CFP.
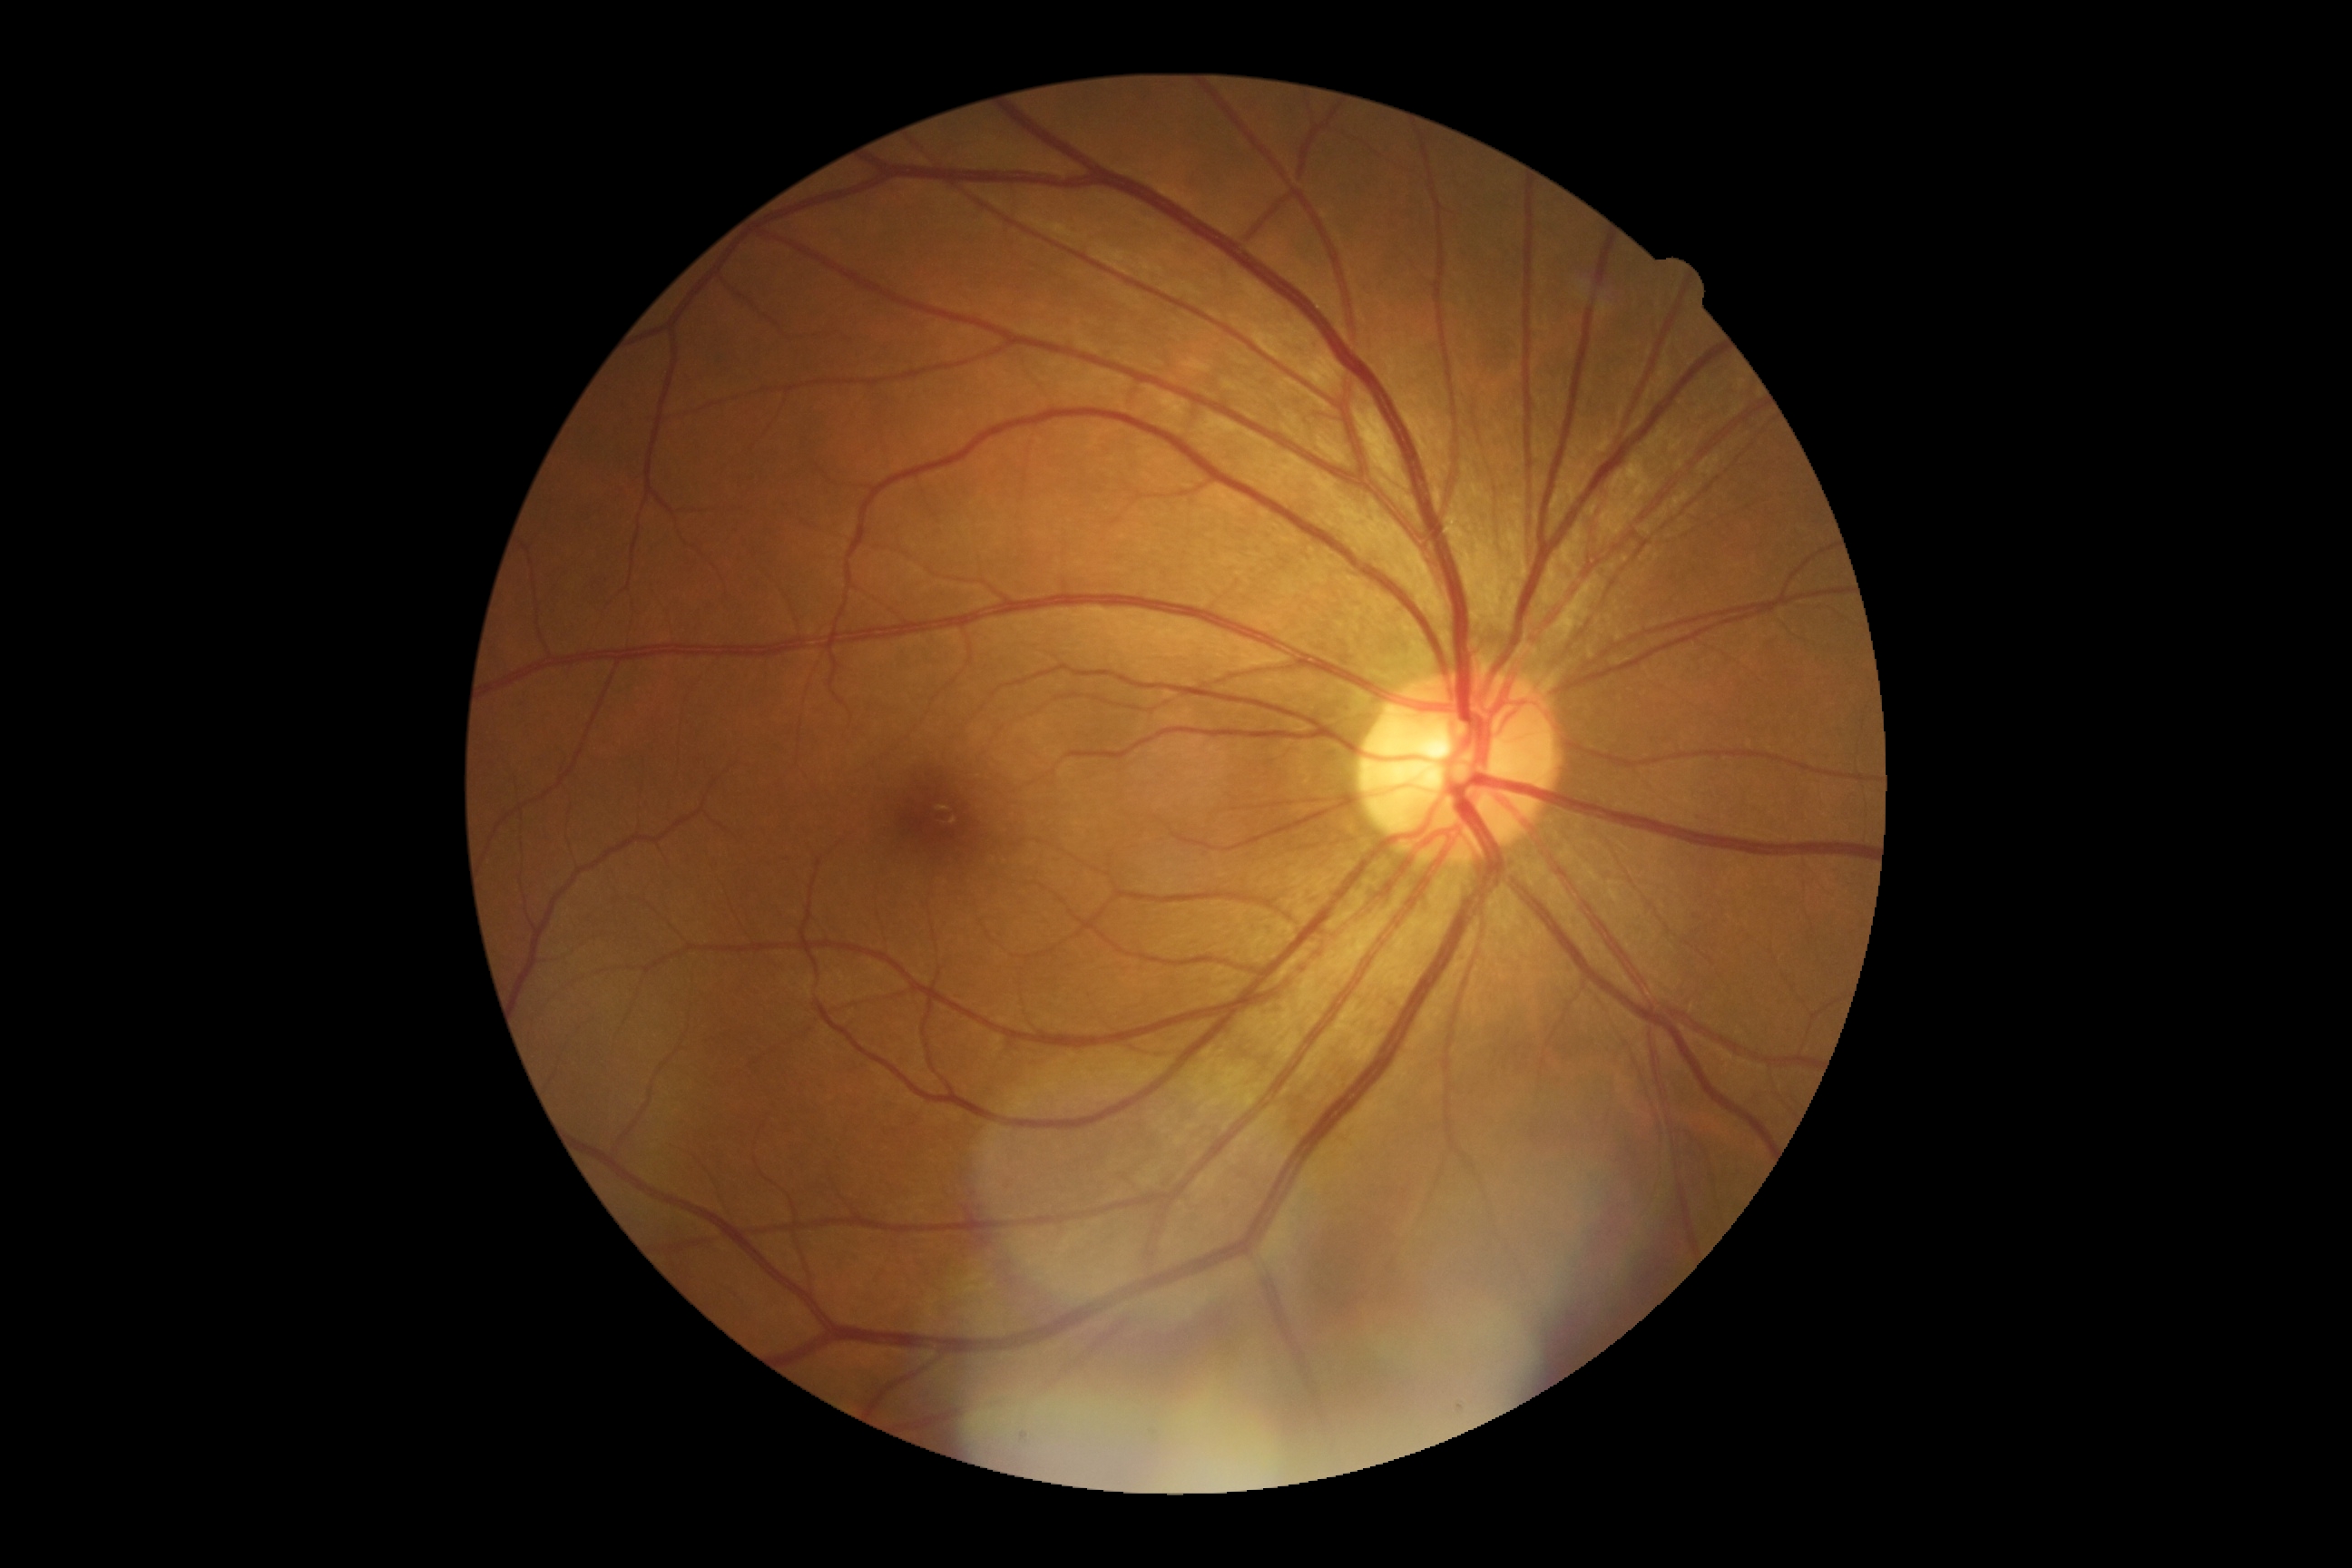
Diabetic retinopathy grade is no apparent diabetic retinopathy (0).